45-degree field of view; CFP — 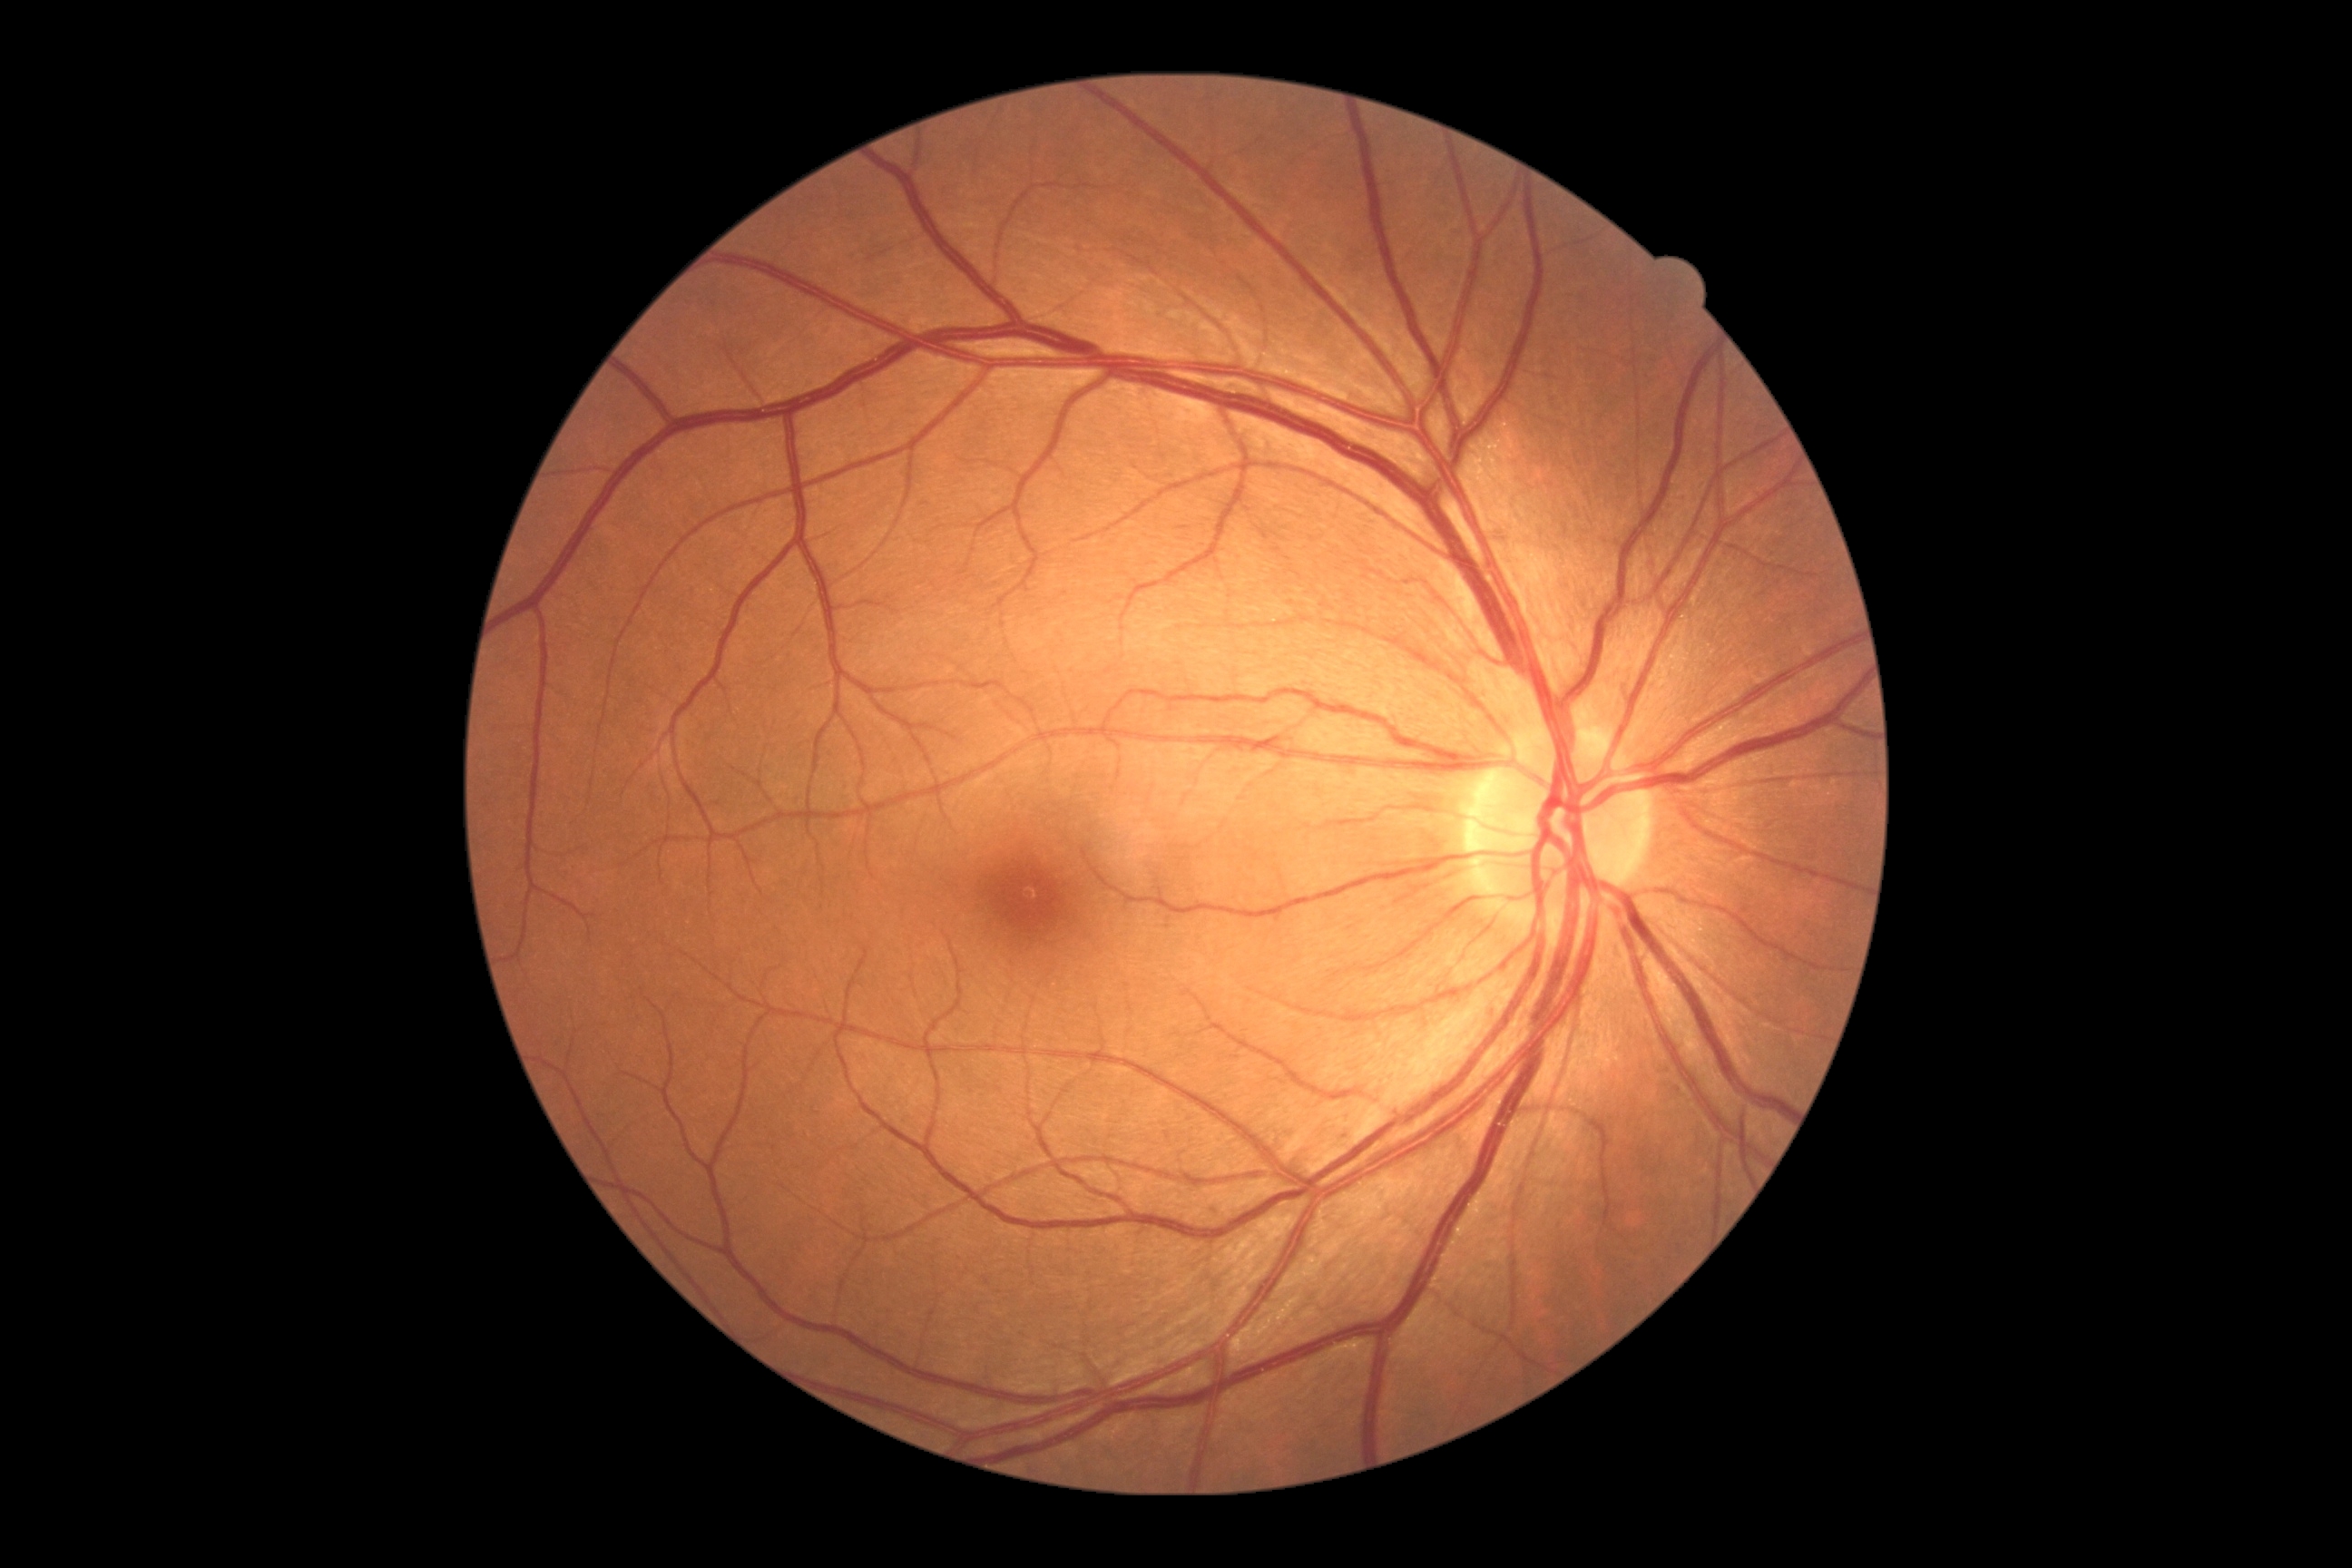
DR is 1/4.